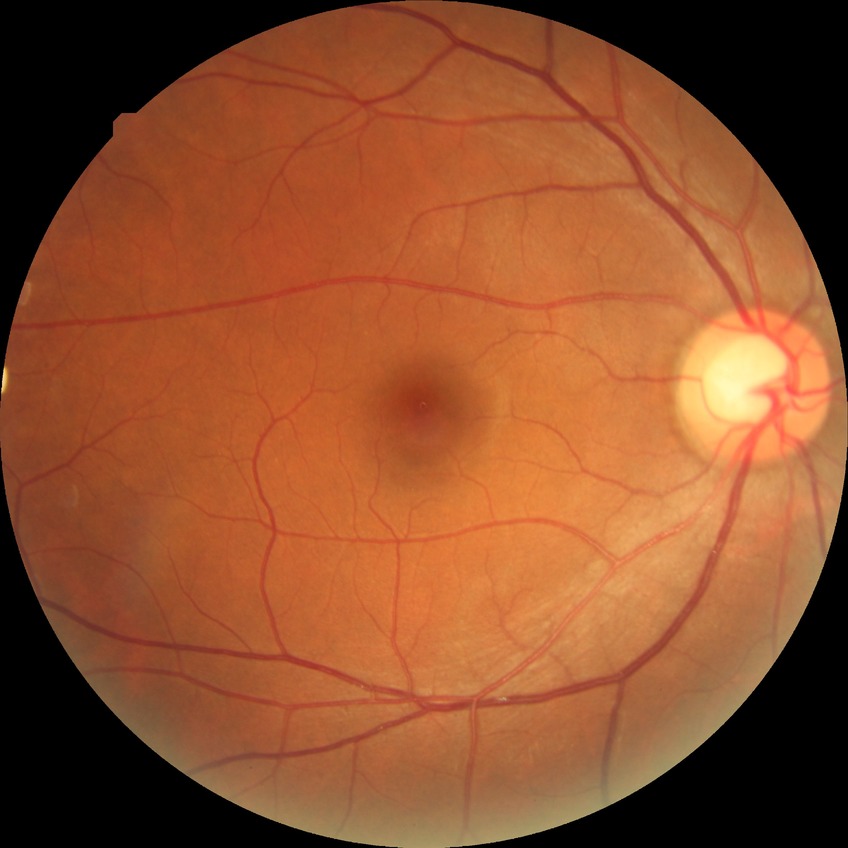
Modified Davis classification is no diabetic retinopathy.